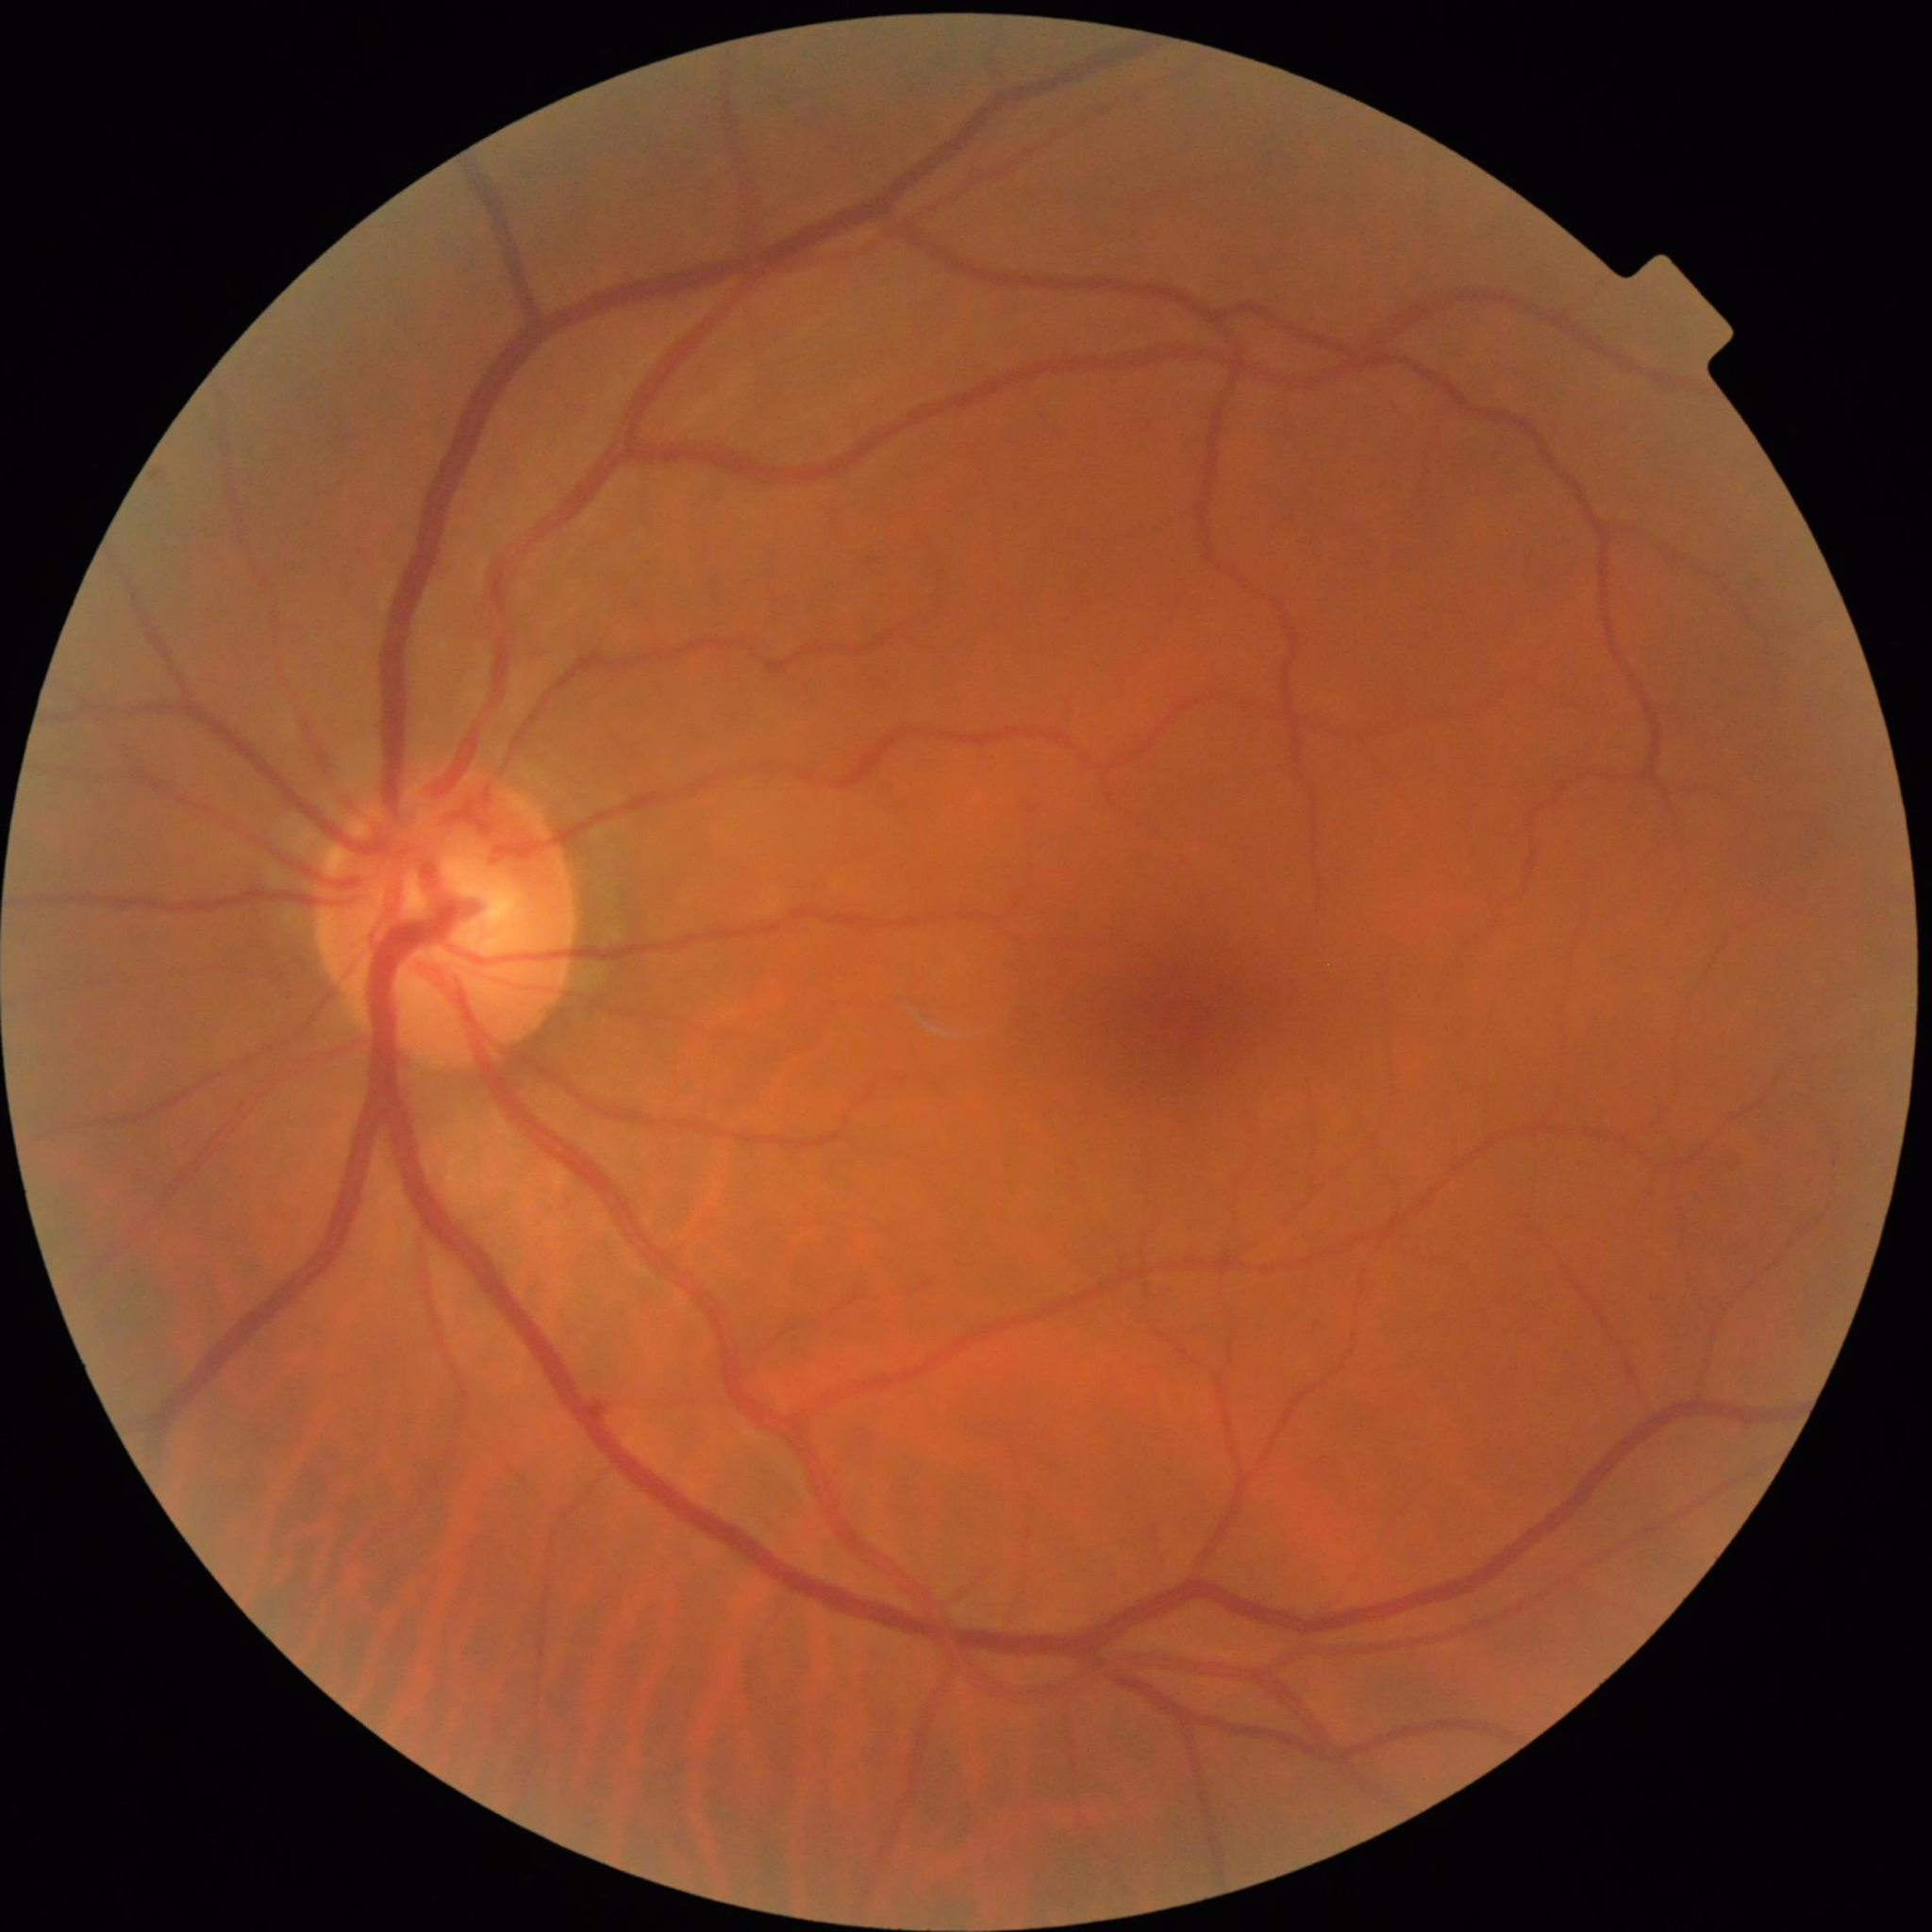

Impression: no AMD, DR, or glaucomatous findings; Automated quality assessment: no quality issues identified.